NIDEK AFC-230 fundus camera; posterior pole color fundus photograph; nonmydriatic
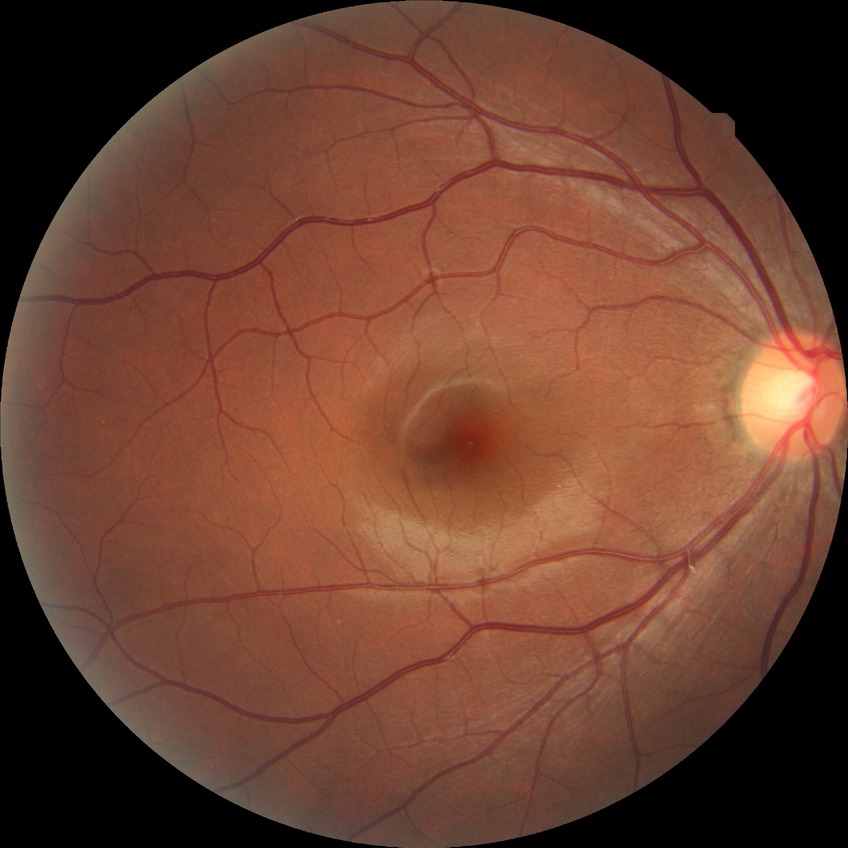
Diabetic retinopathy (DR): NDR (no diabetic retinopathy).